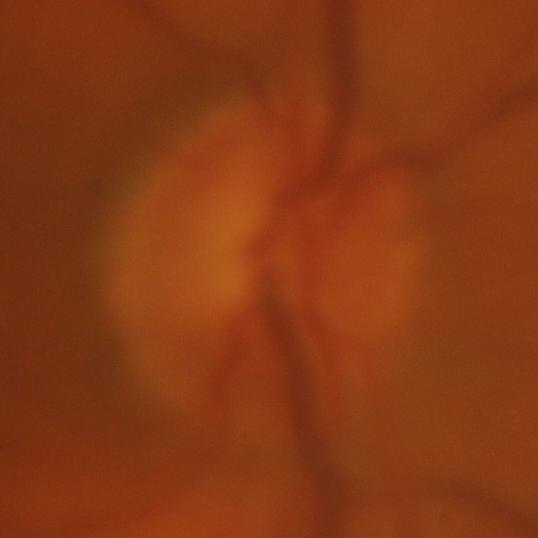

Finding: glaucomatous findings.